Color fundus image: 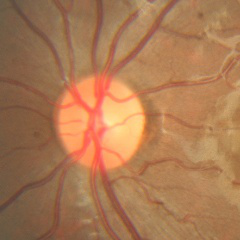
Showing no glaucoma.